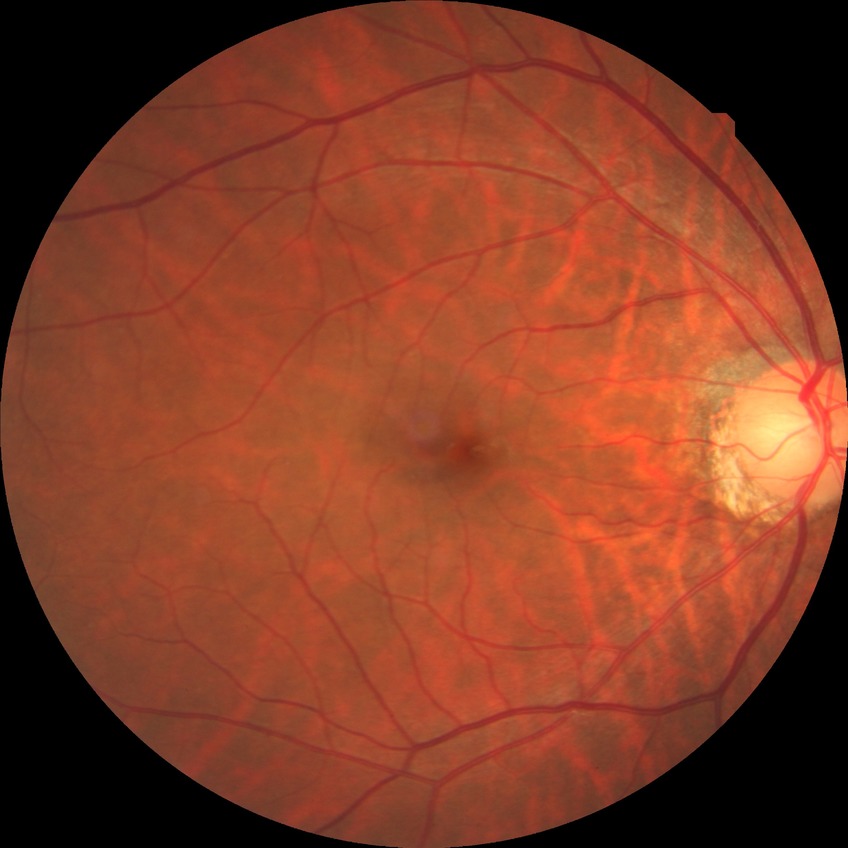
Assessment:
* diabetic retinopathy severity: no diabetic retinopathy